2102x1736 · color fundus photograph.
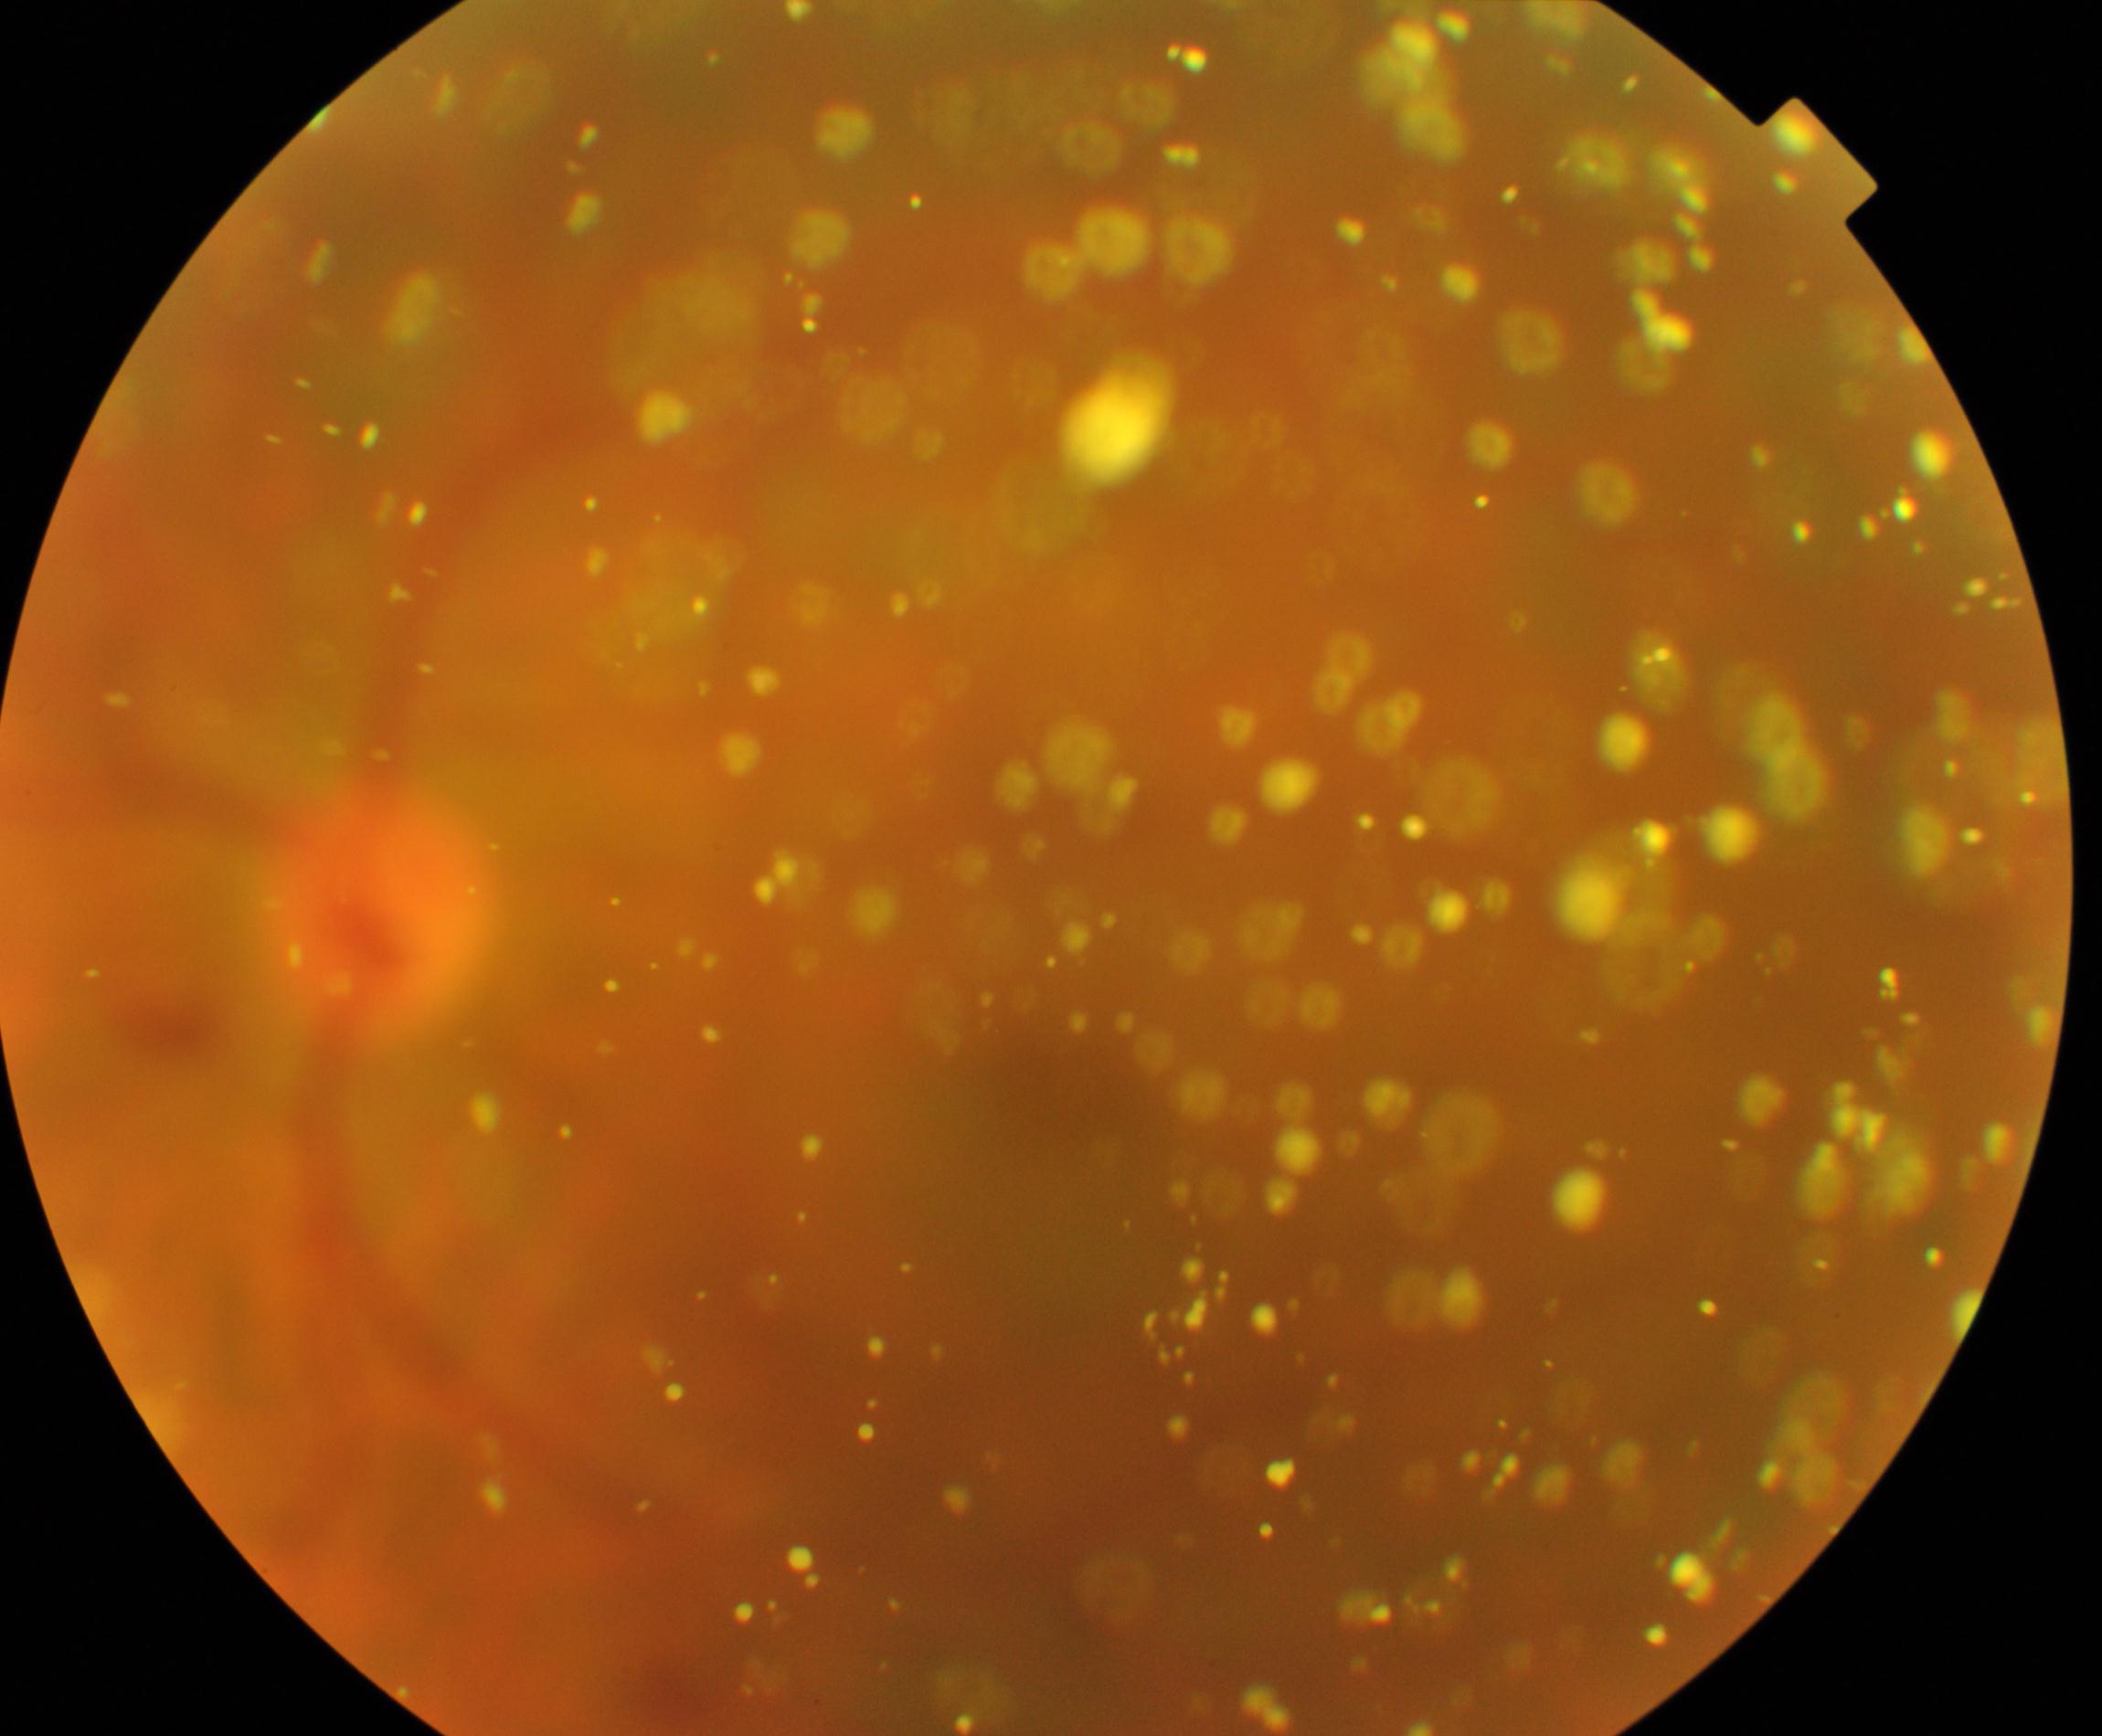

Primary finding: vitreous particles.